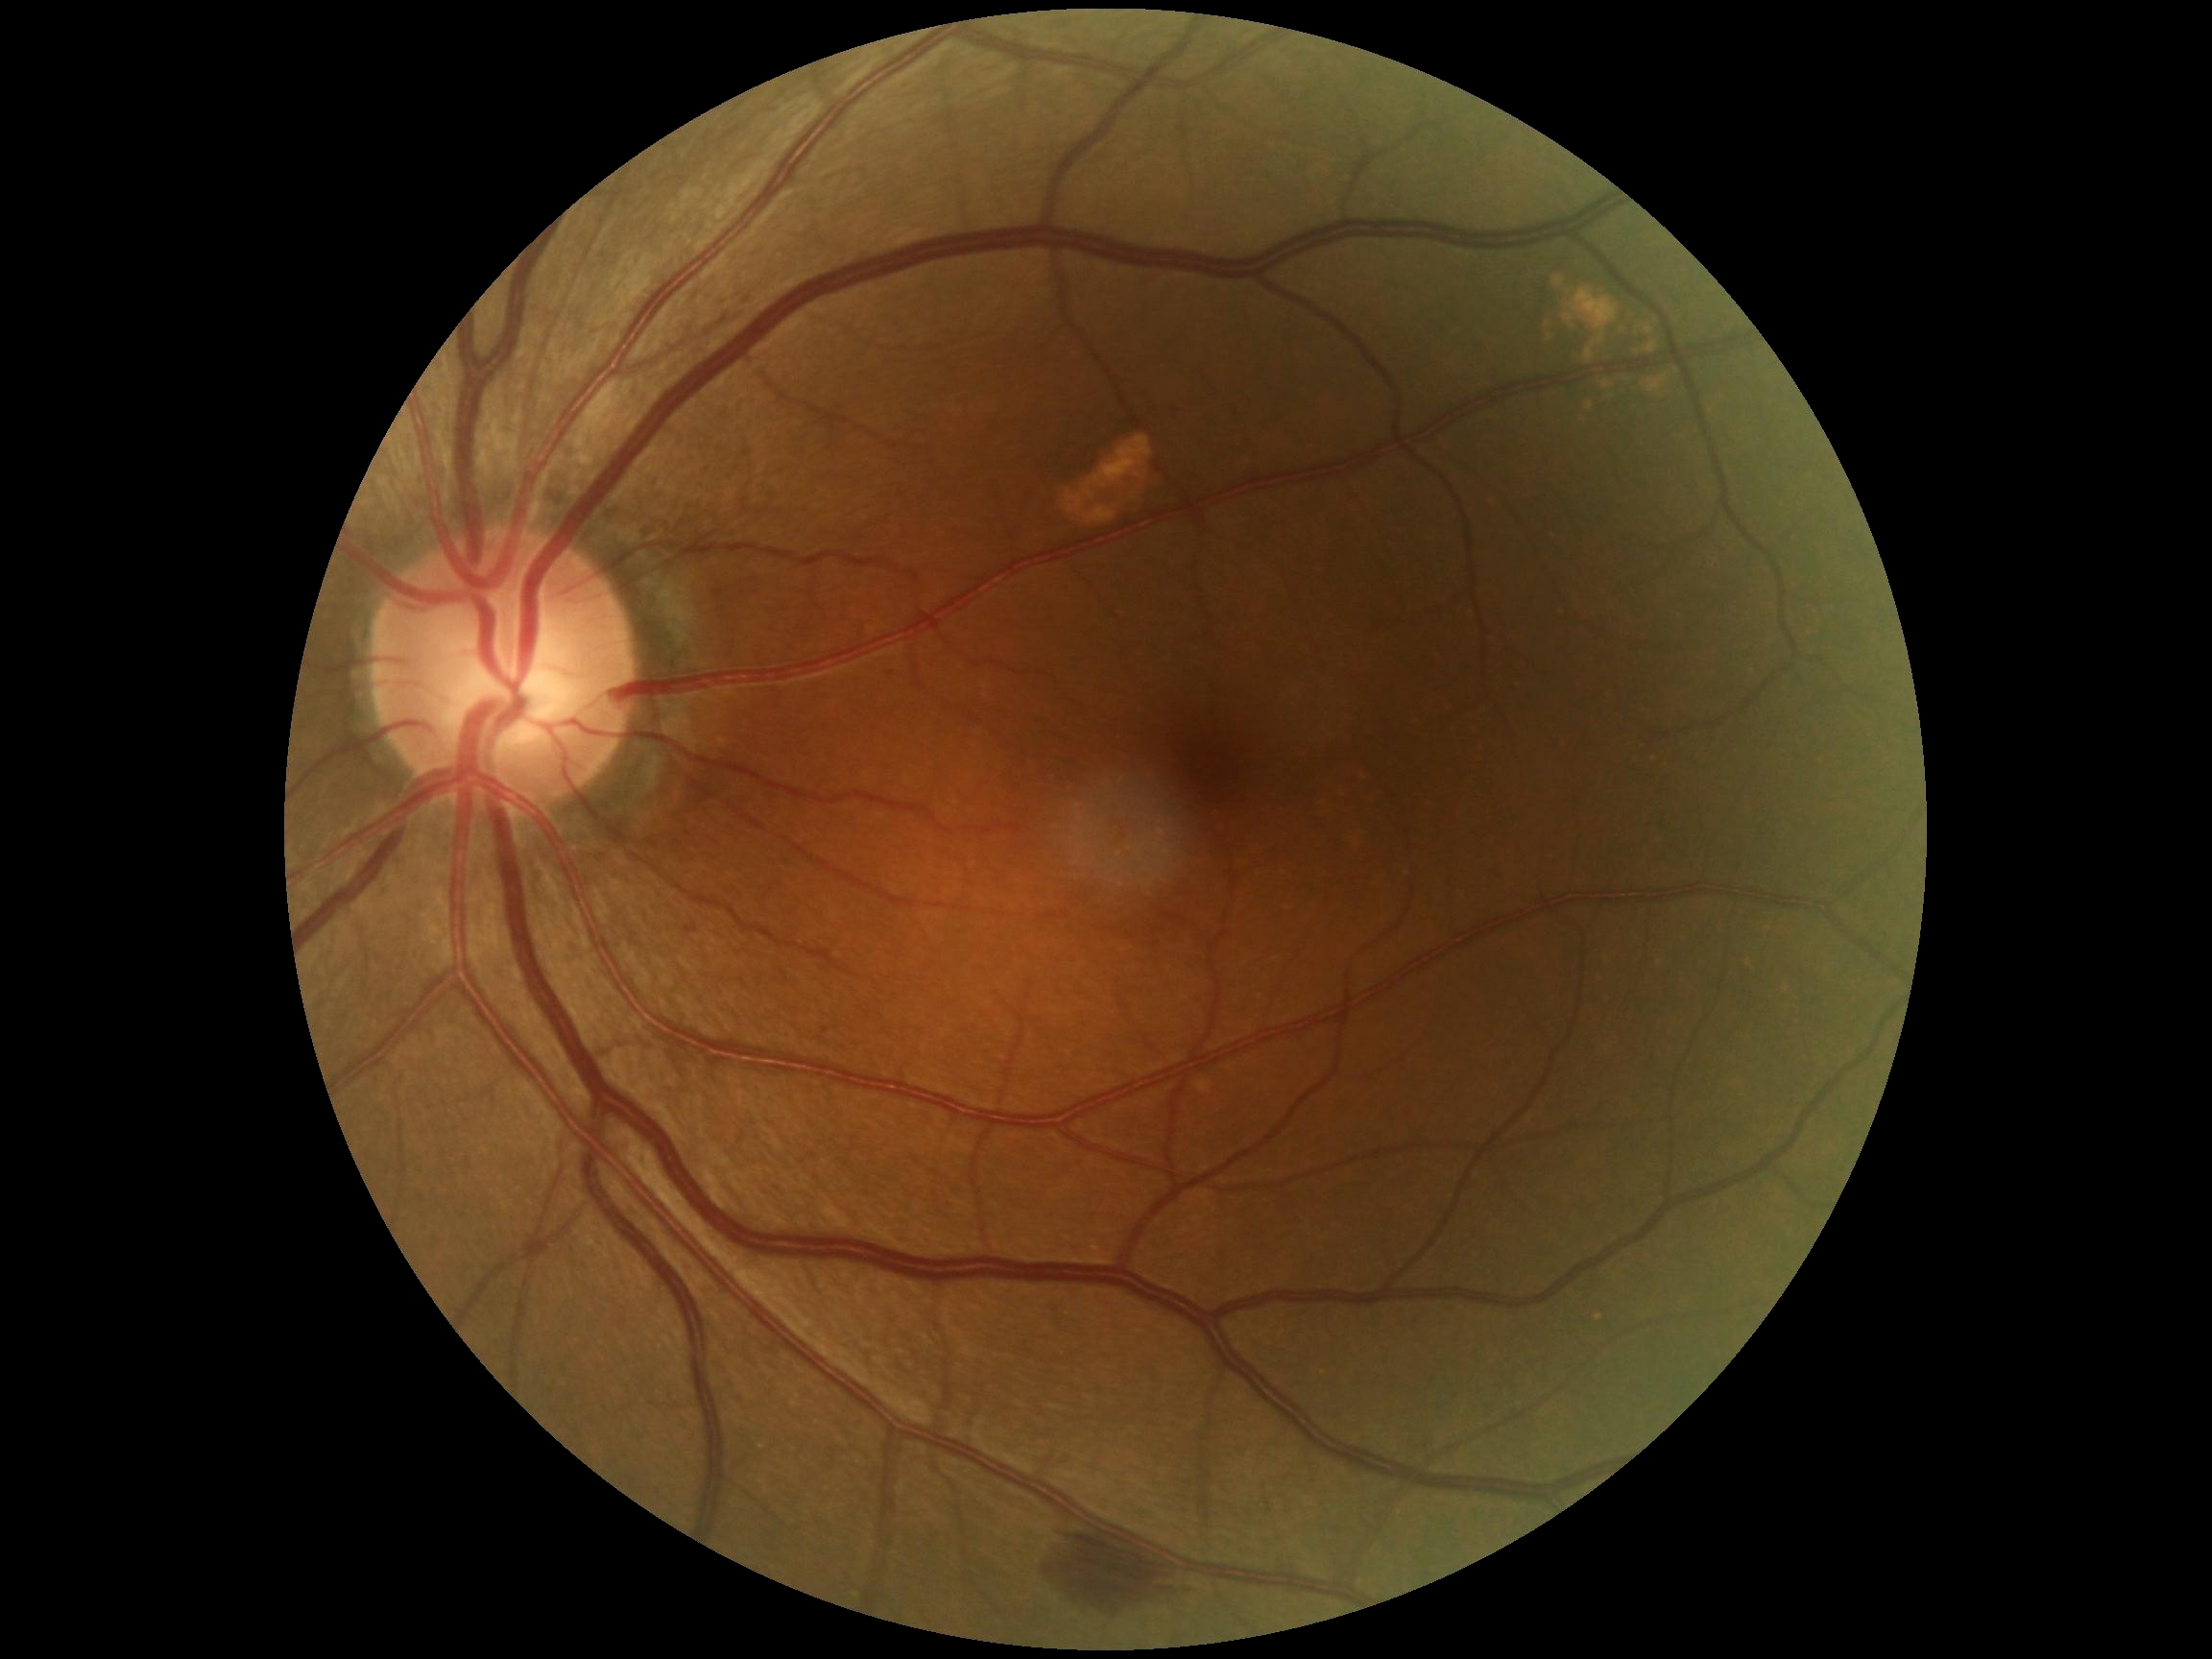

  dr_grade: 2/4
  dr_category: non-proliferative diabetic retinopathy